Without pupil dilation. NIDEK AFC-230.
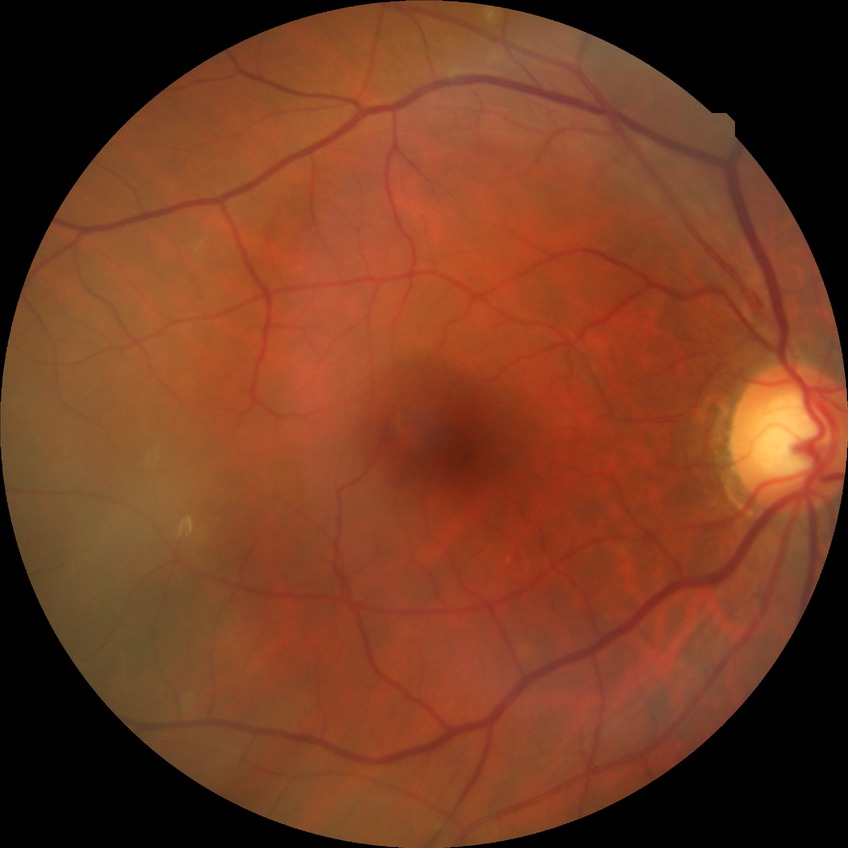

Diabetic retinopathy (DR): no diabetic retinopathy (NDR).